Retinal fundus photograph. 2212 by 1659 pixels. 45-degree field of view.
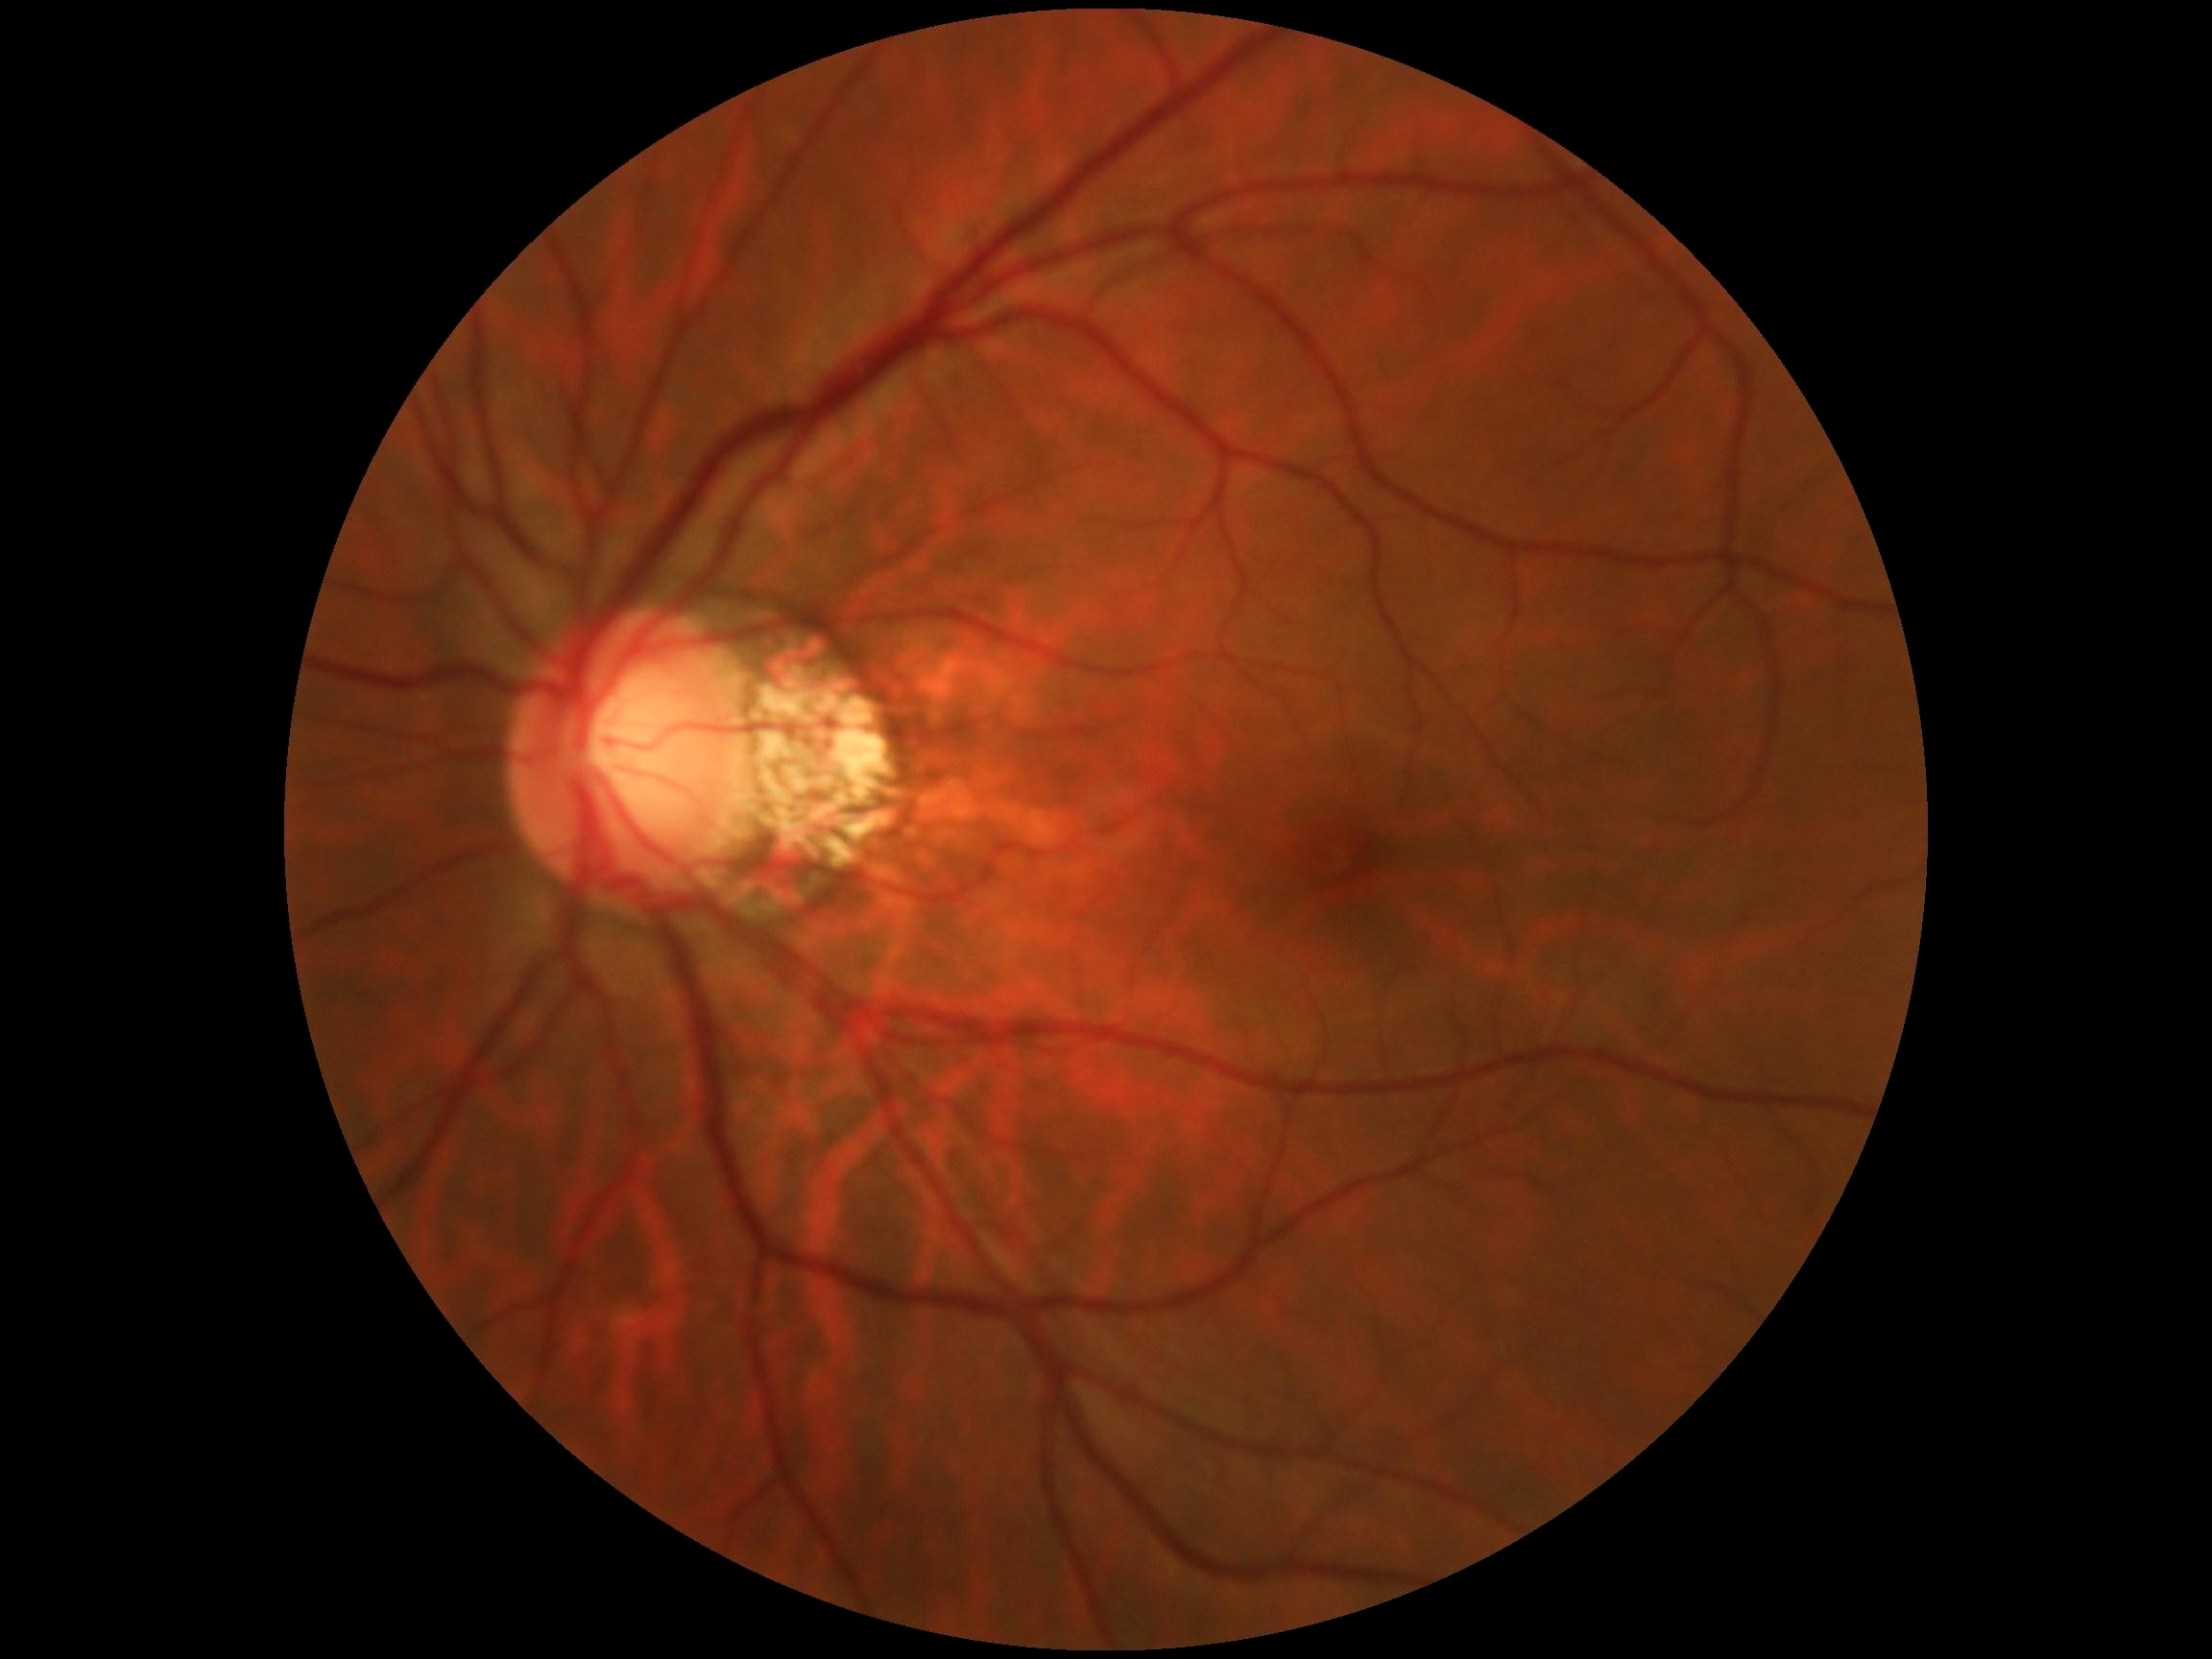 Diabetic retinopathy: 0/4 — no visible signs of diabetic retinopathy.